FOV: 45 degrees; 2352 x 1568 pixels; color fundus photograph:
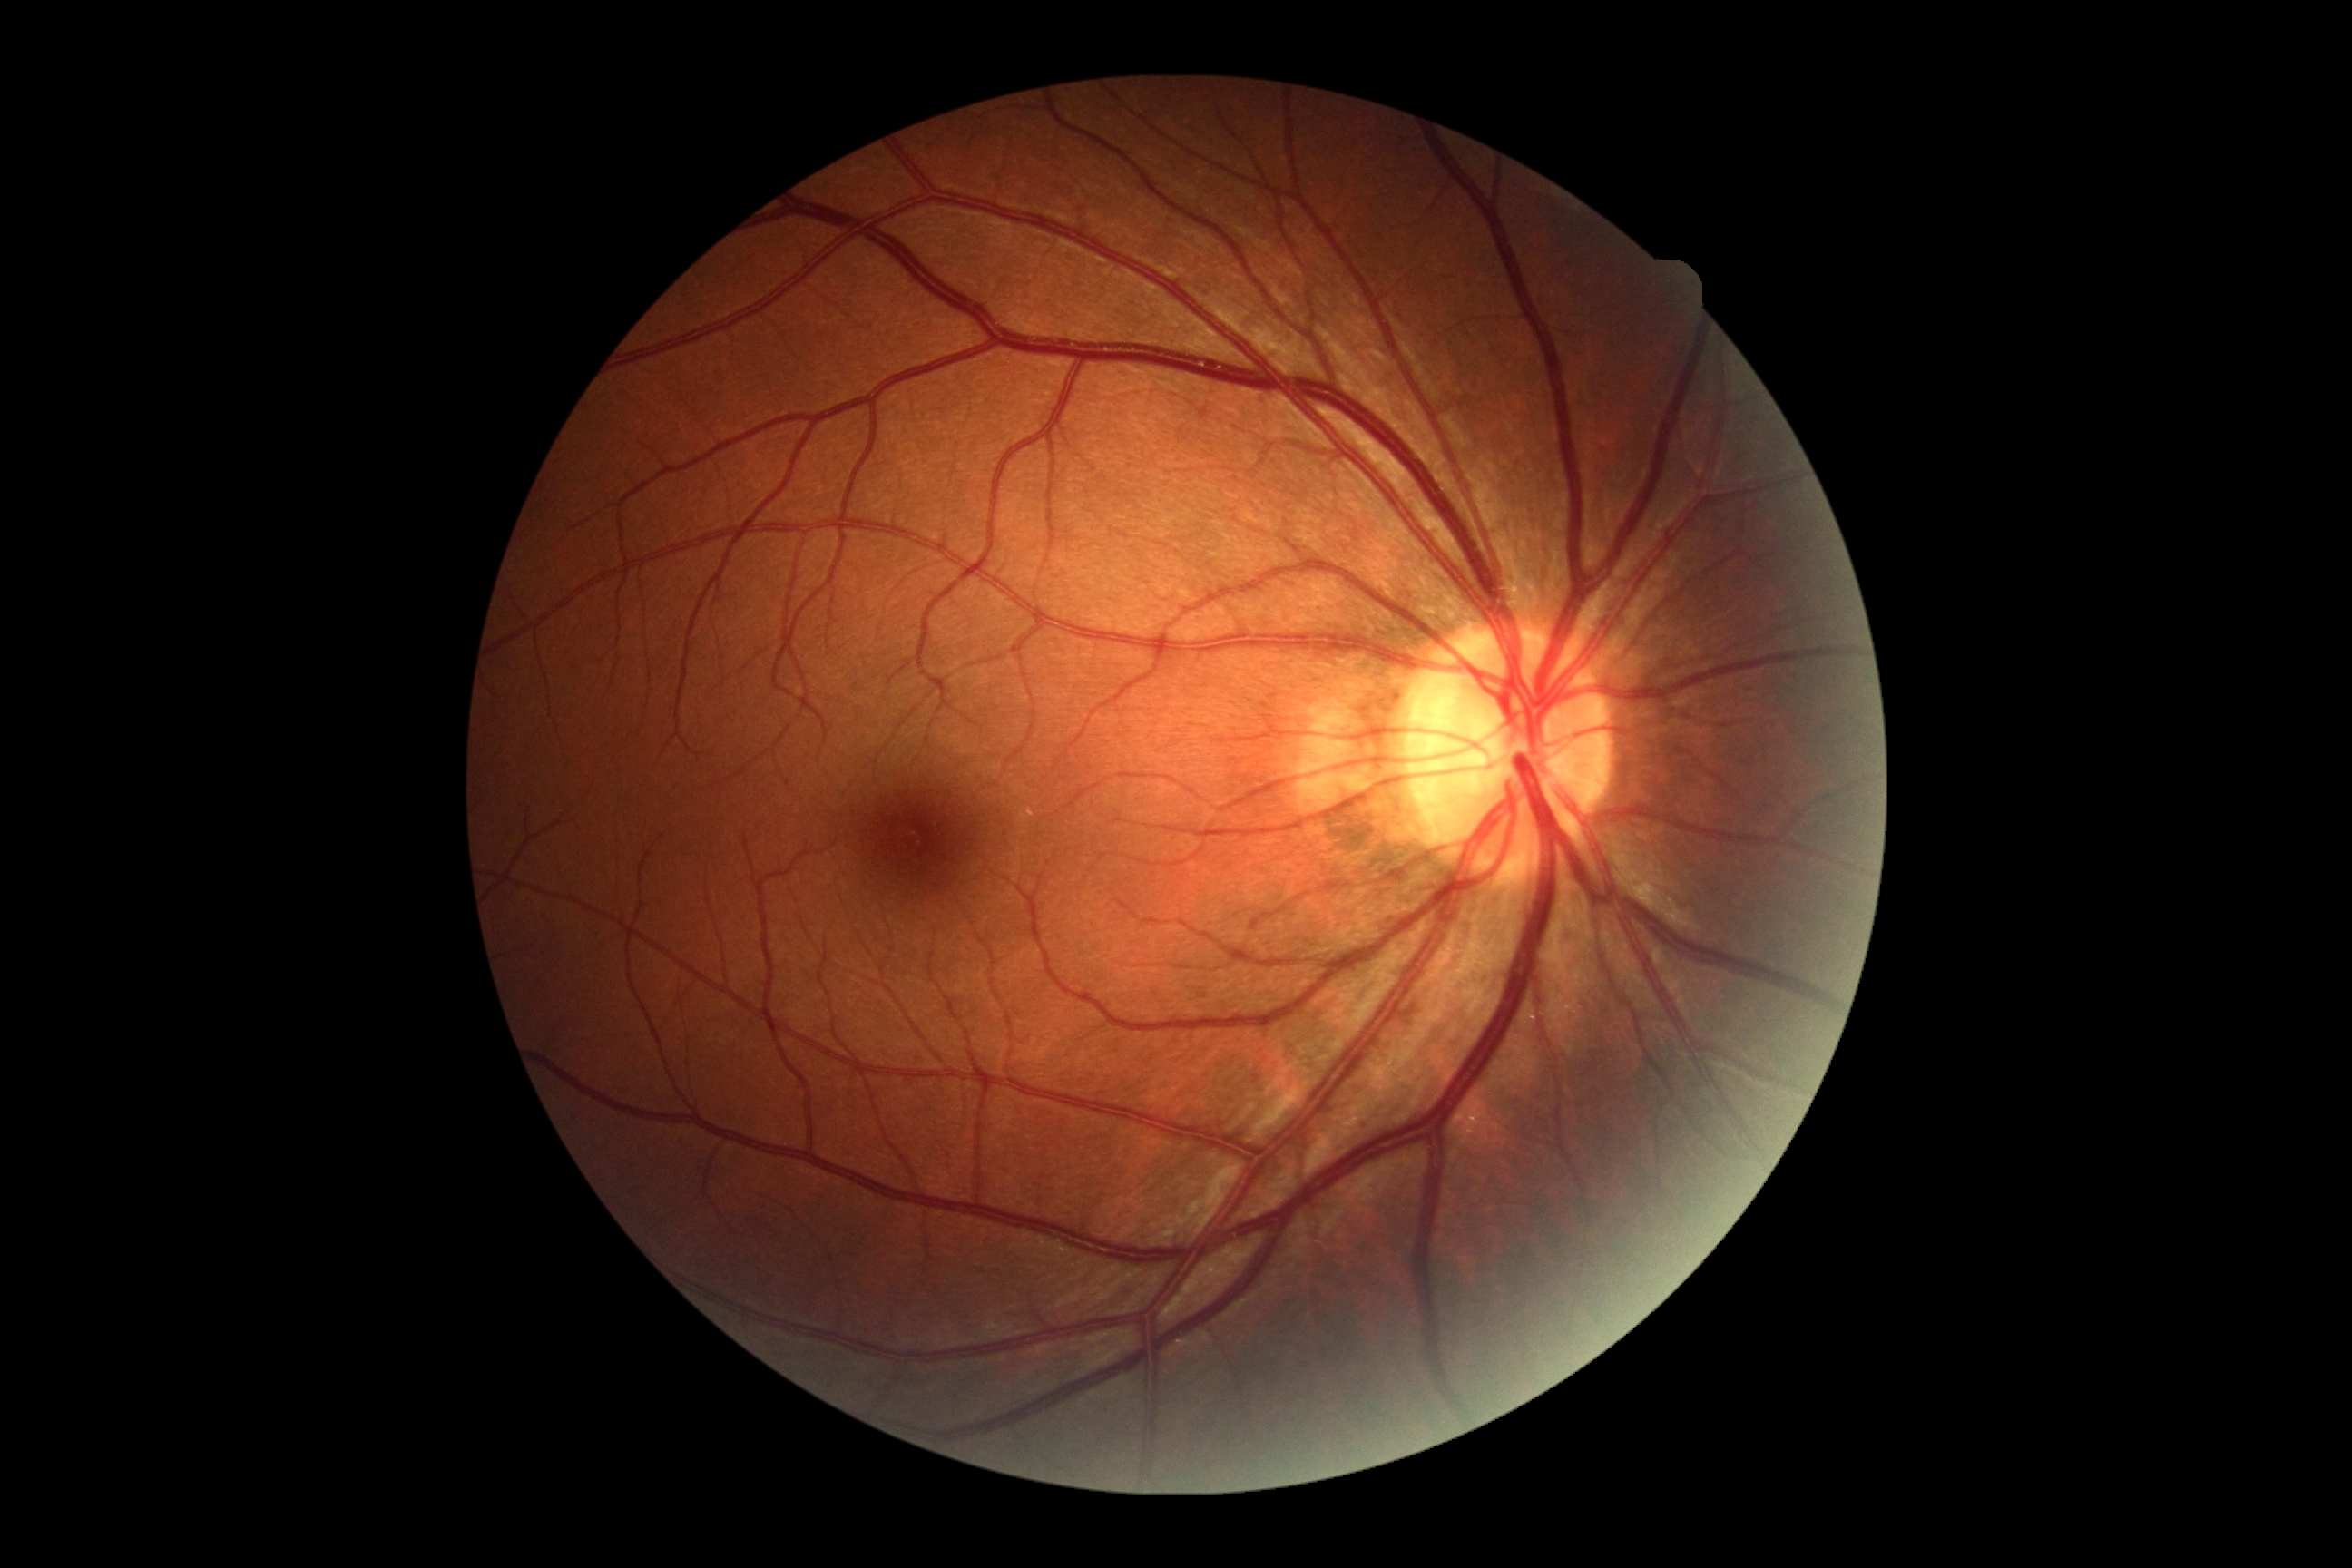

DR severity: grade 0.